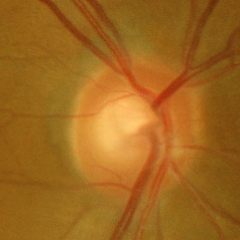 The image shows no glaucomatous changes.